Retinal fundus photograph.
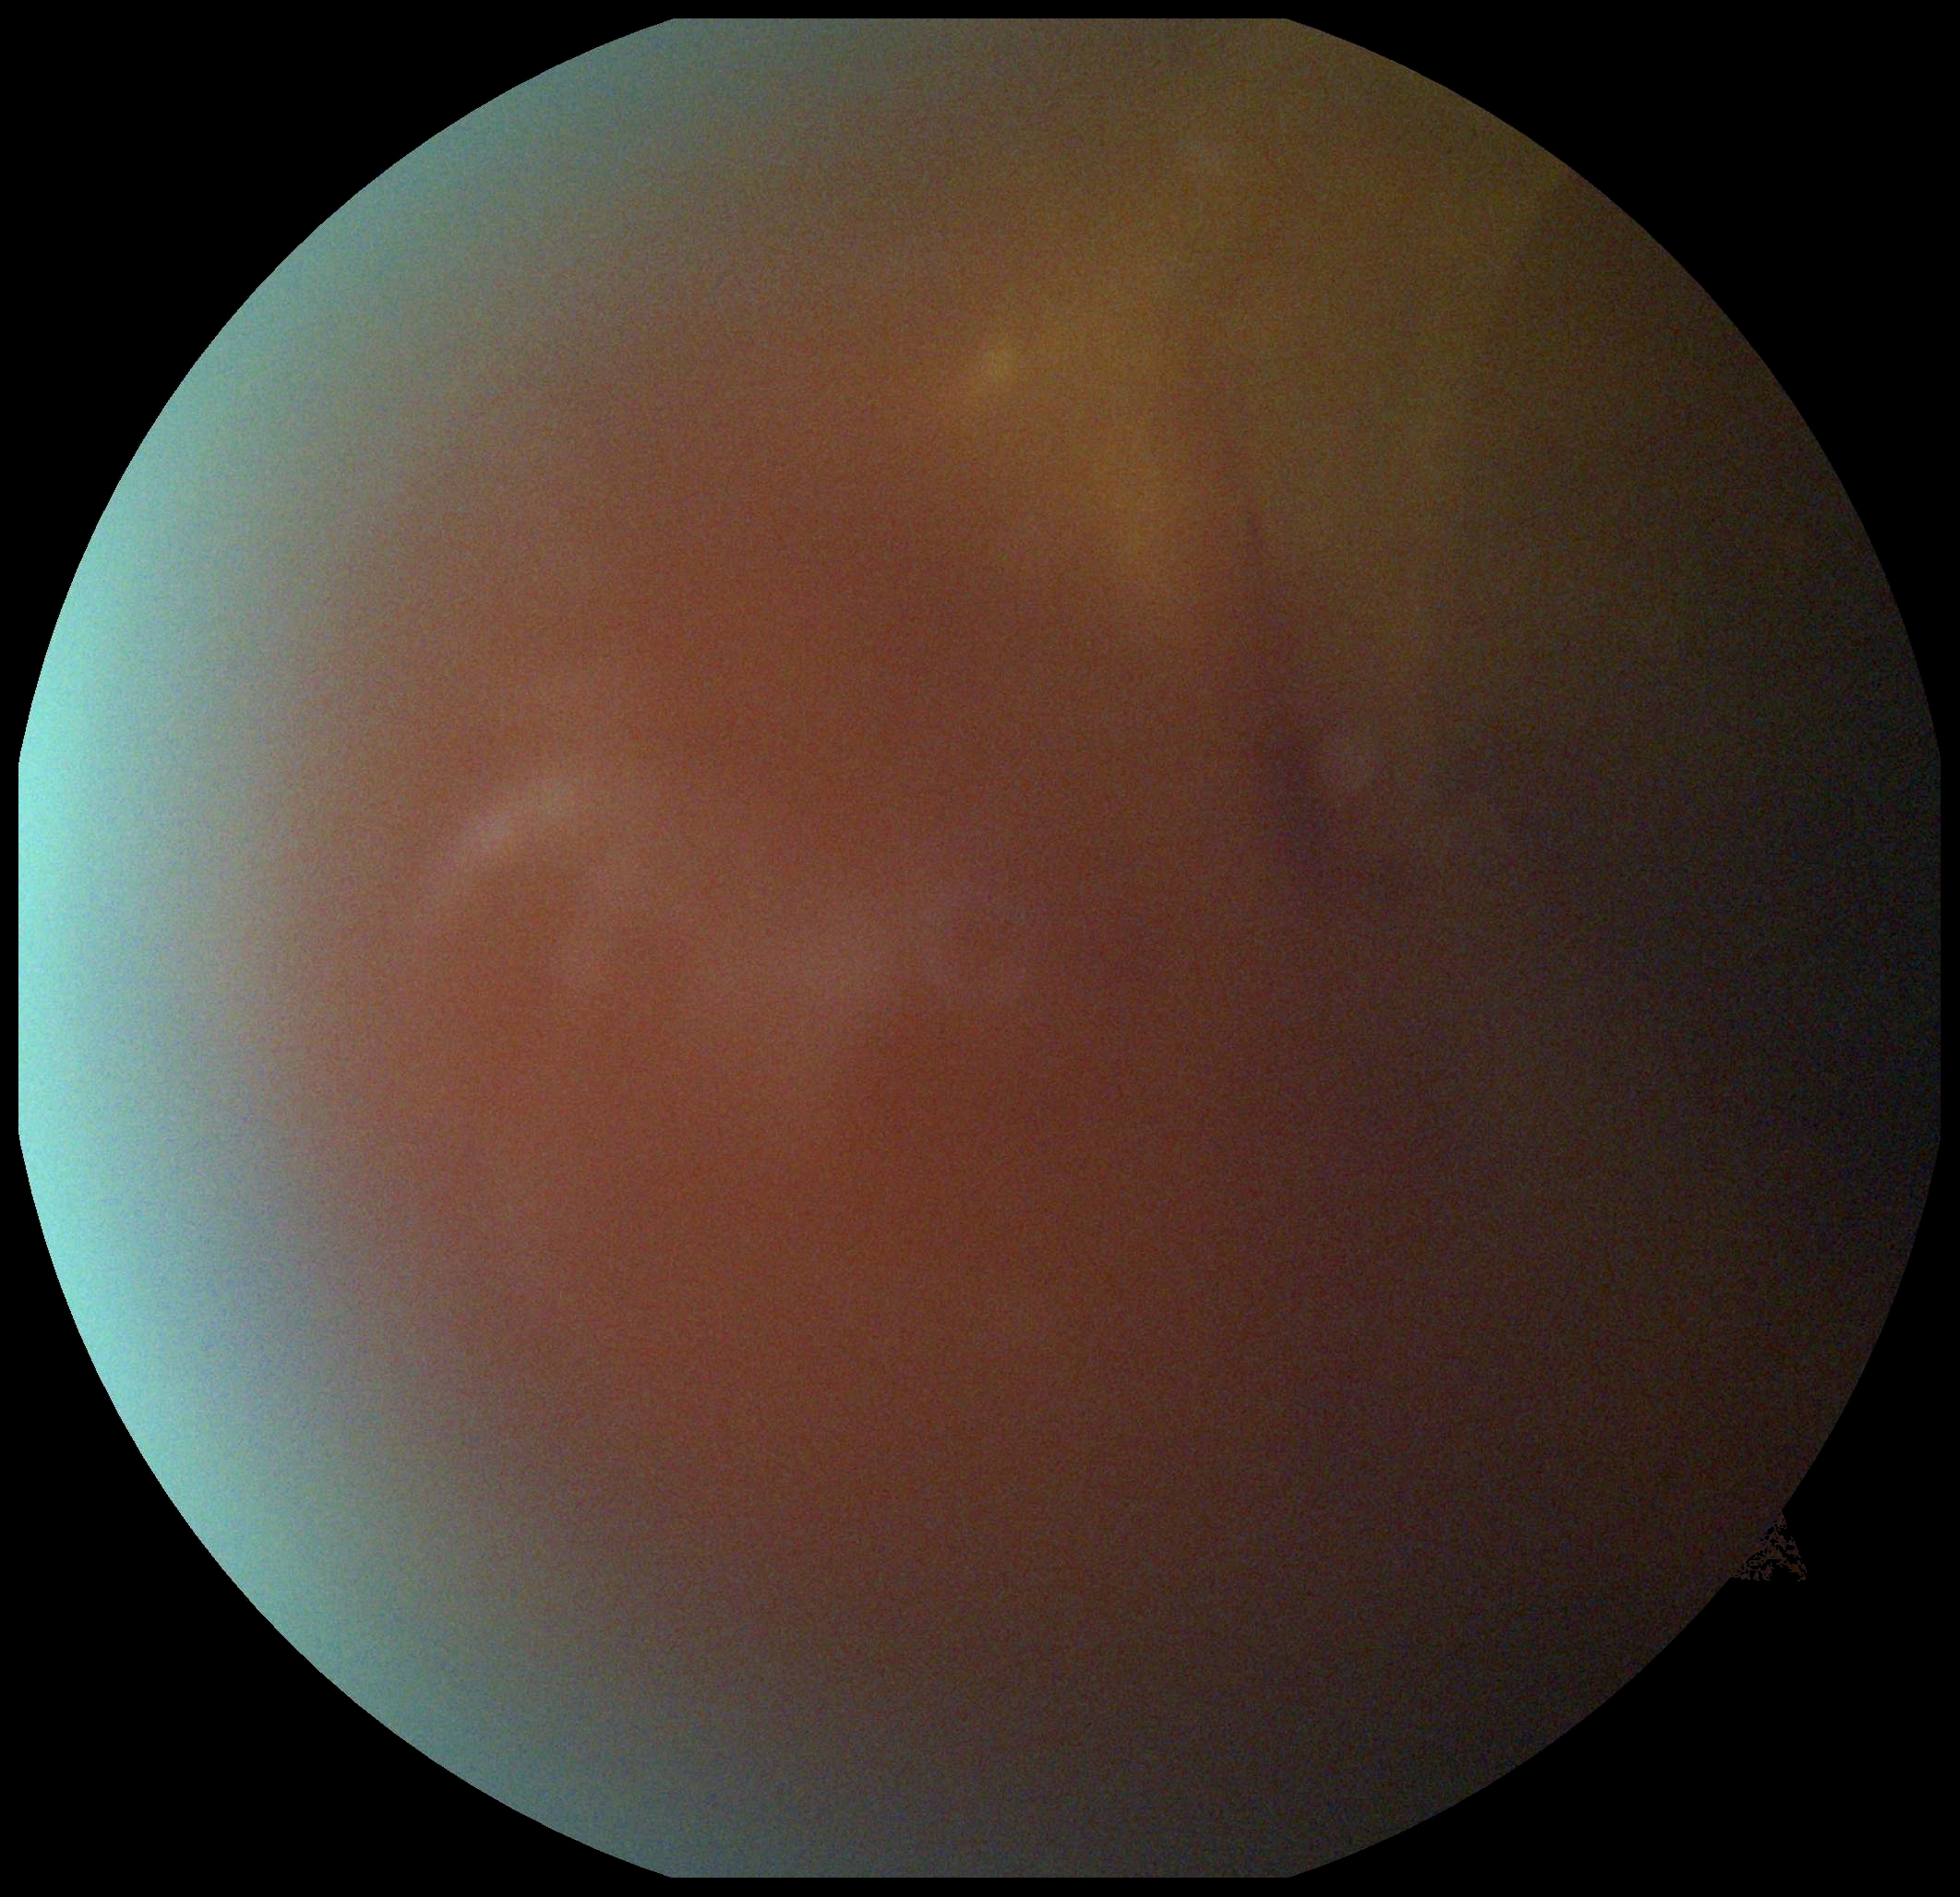

image quality = too poor for DR grading | diabetic retinopathy = ungradable.